Diabetic retinopathy graded by the modified Davis classification:
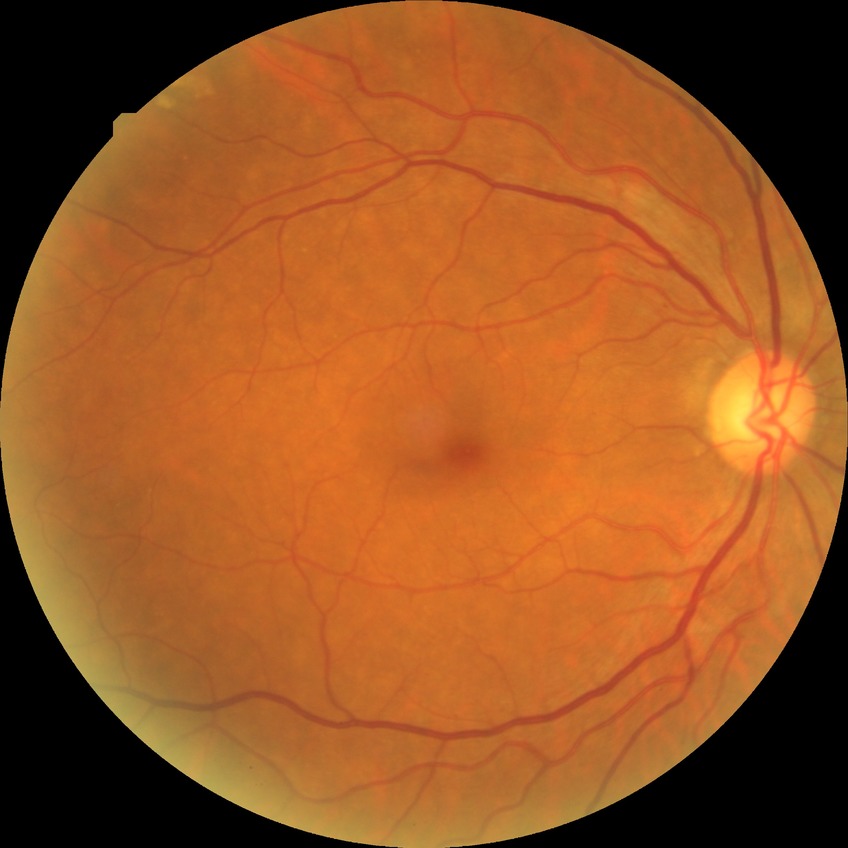

{"davis_grade": "no diabetic retinopathy (NDR)"}